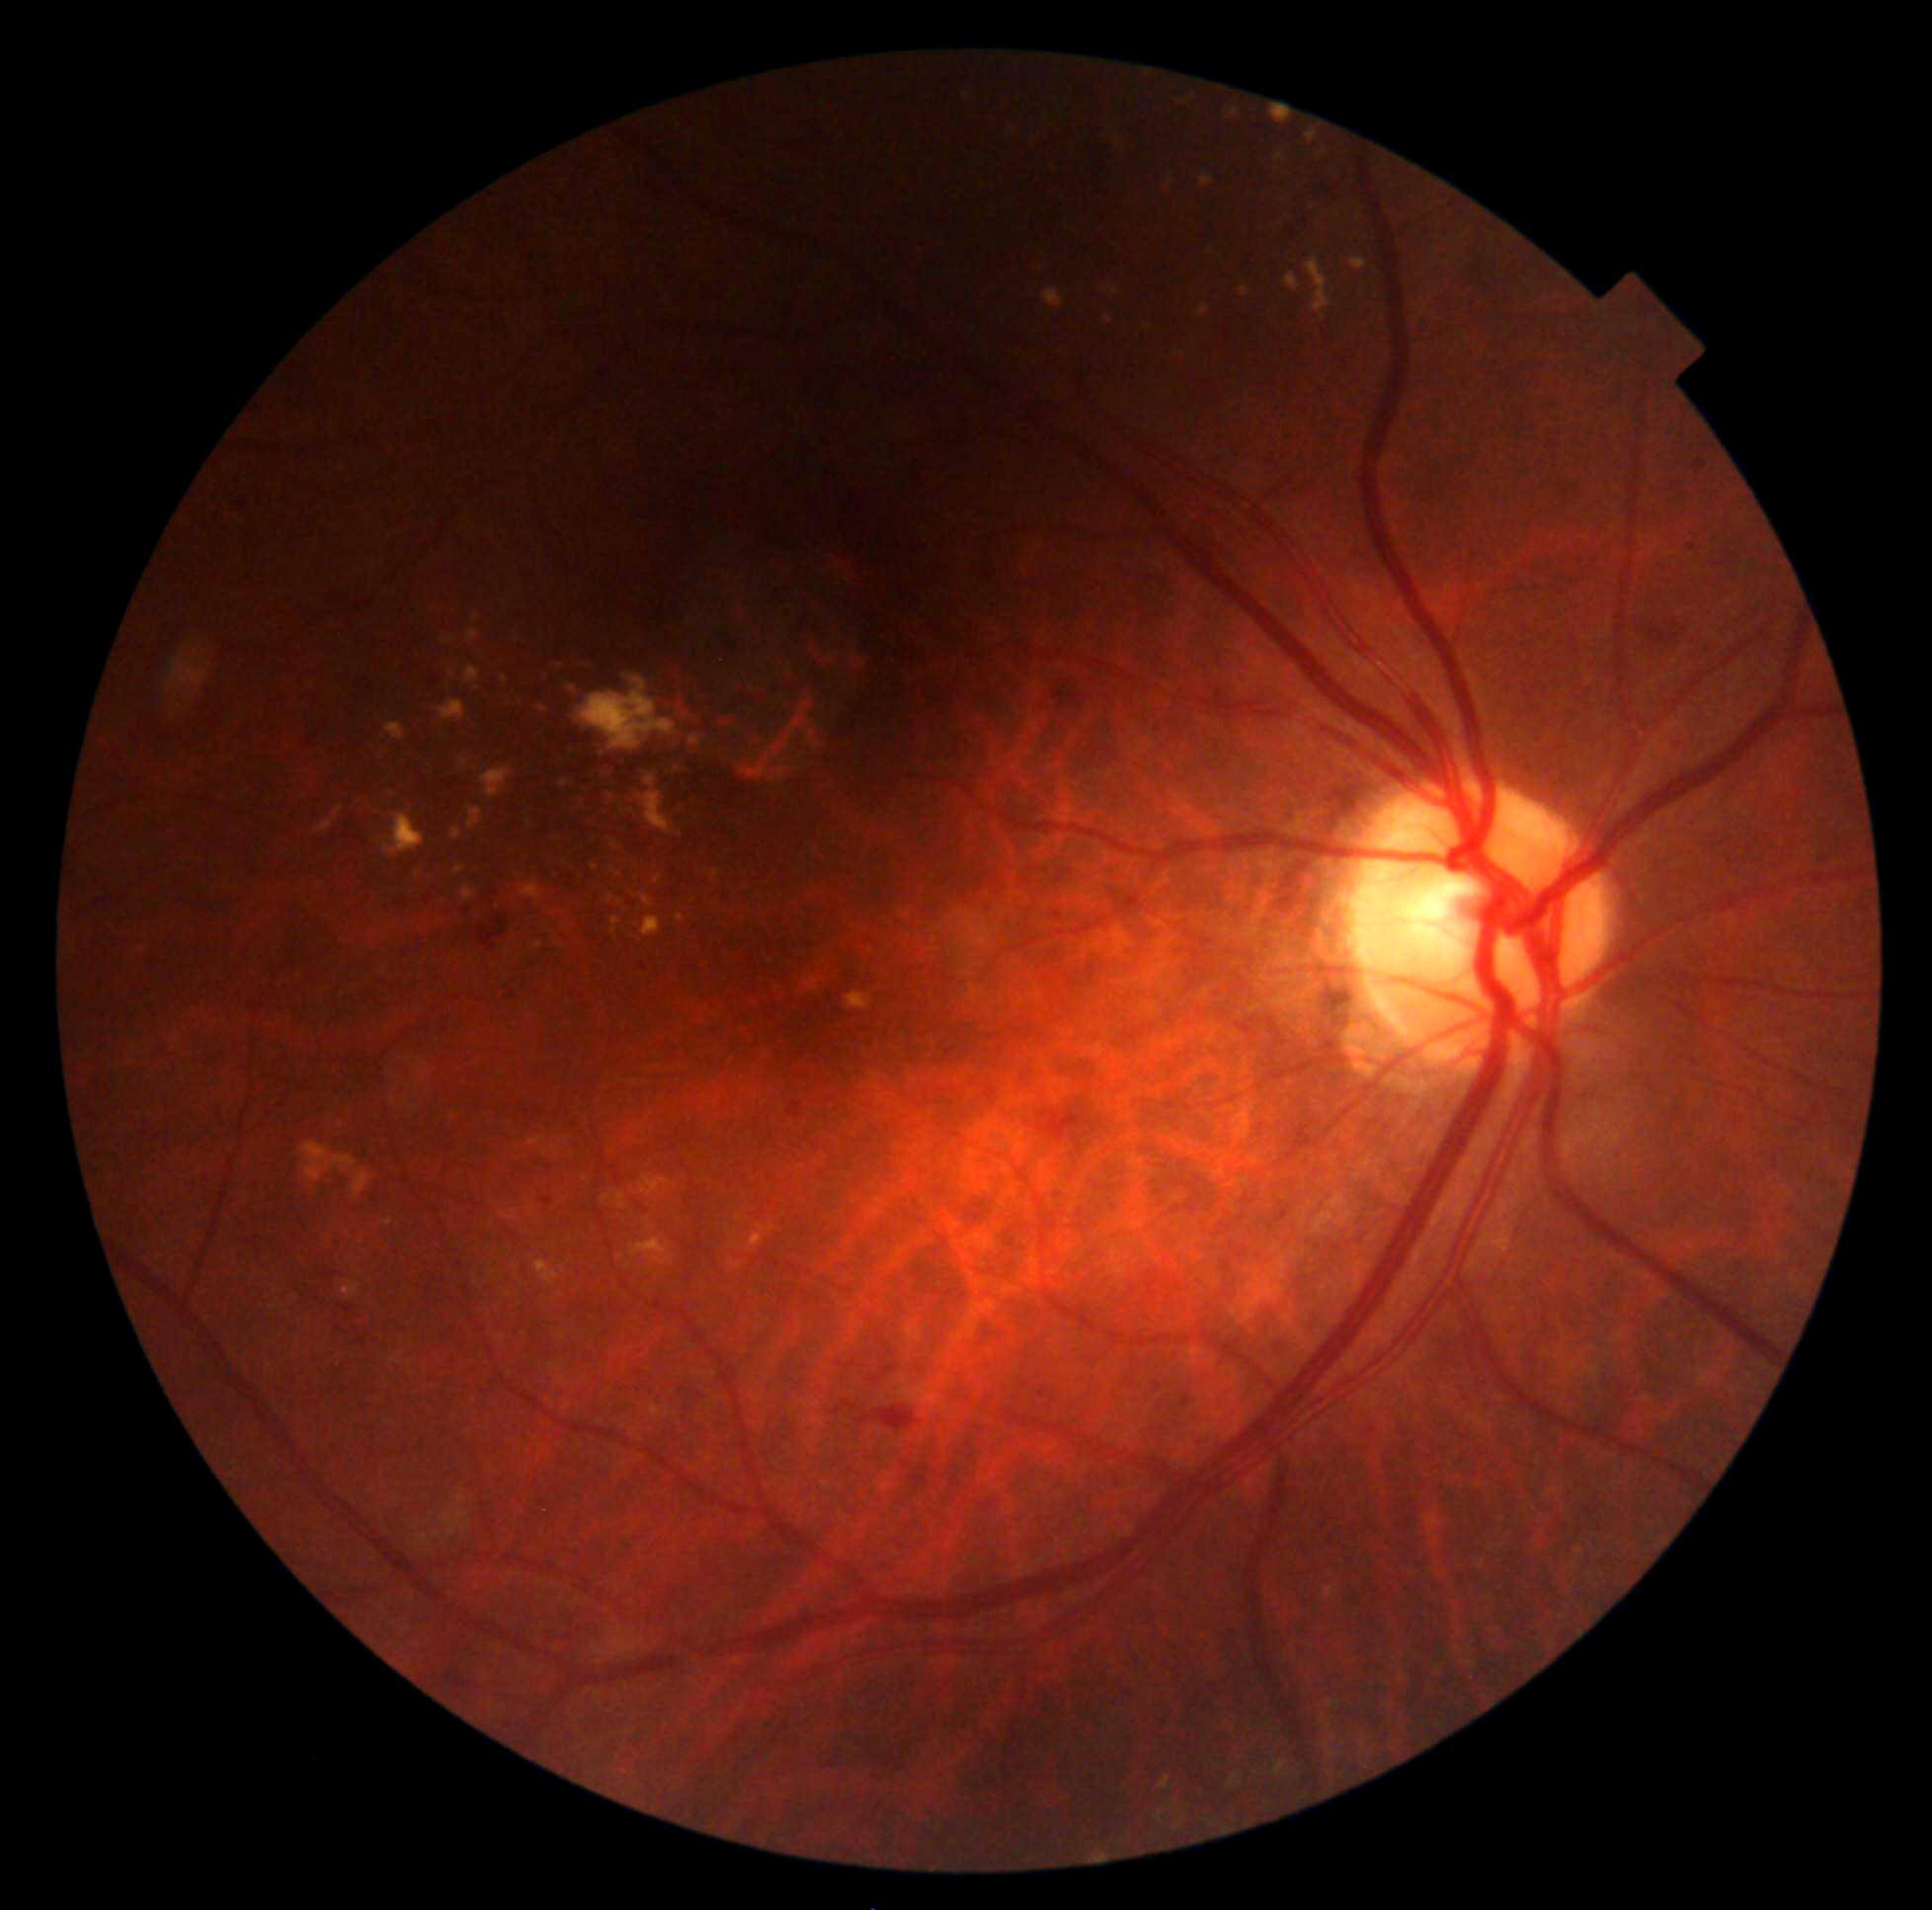 DR severity is moderate NPDR (grade 2) — more than just microaneurysms but less than severe NPDR
Representative lesions:
EXs (more not shown): (1275, 154, 1286, 163), (302, 1143, 359, 1182), (522, 884, 541, 901), (453, 829, 462, 839), (1225, 106, 1241, 117), (1317, 149, 1328, 160), (789, 723, 800, 736), (640, 893, 654, 910), (611, 841, 616, 850), (645, 793, 673, 835), (353, 1171, 370, 1198), (807, 732, 814, 743), (1270, 101, 1297, 125), (561, 780, 568, 789), (1045, 288, 1065, 308)
EXs (small, approximate centers) near (x=393, y=795), (x=560, y=1295), (x=681, y=918), (x=788, y=745), (x=818, y=746)